Color fundus image. Acquired with a Remidio Fundus on Phone (FOP) camera
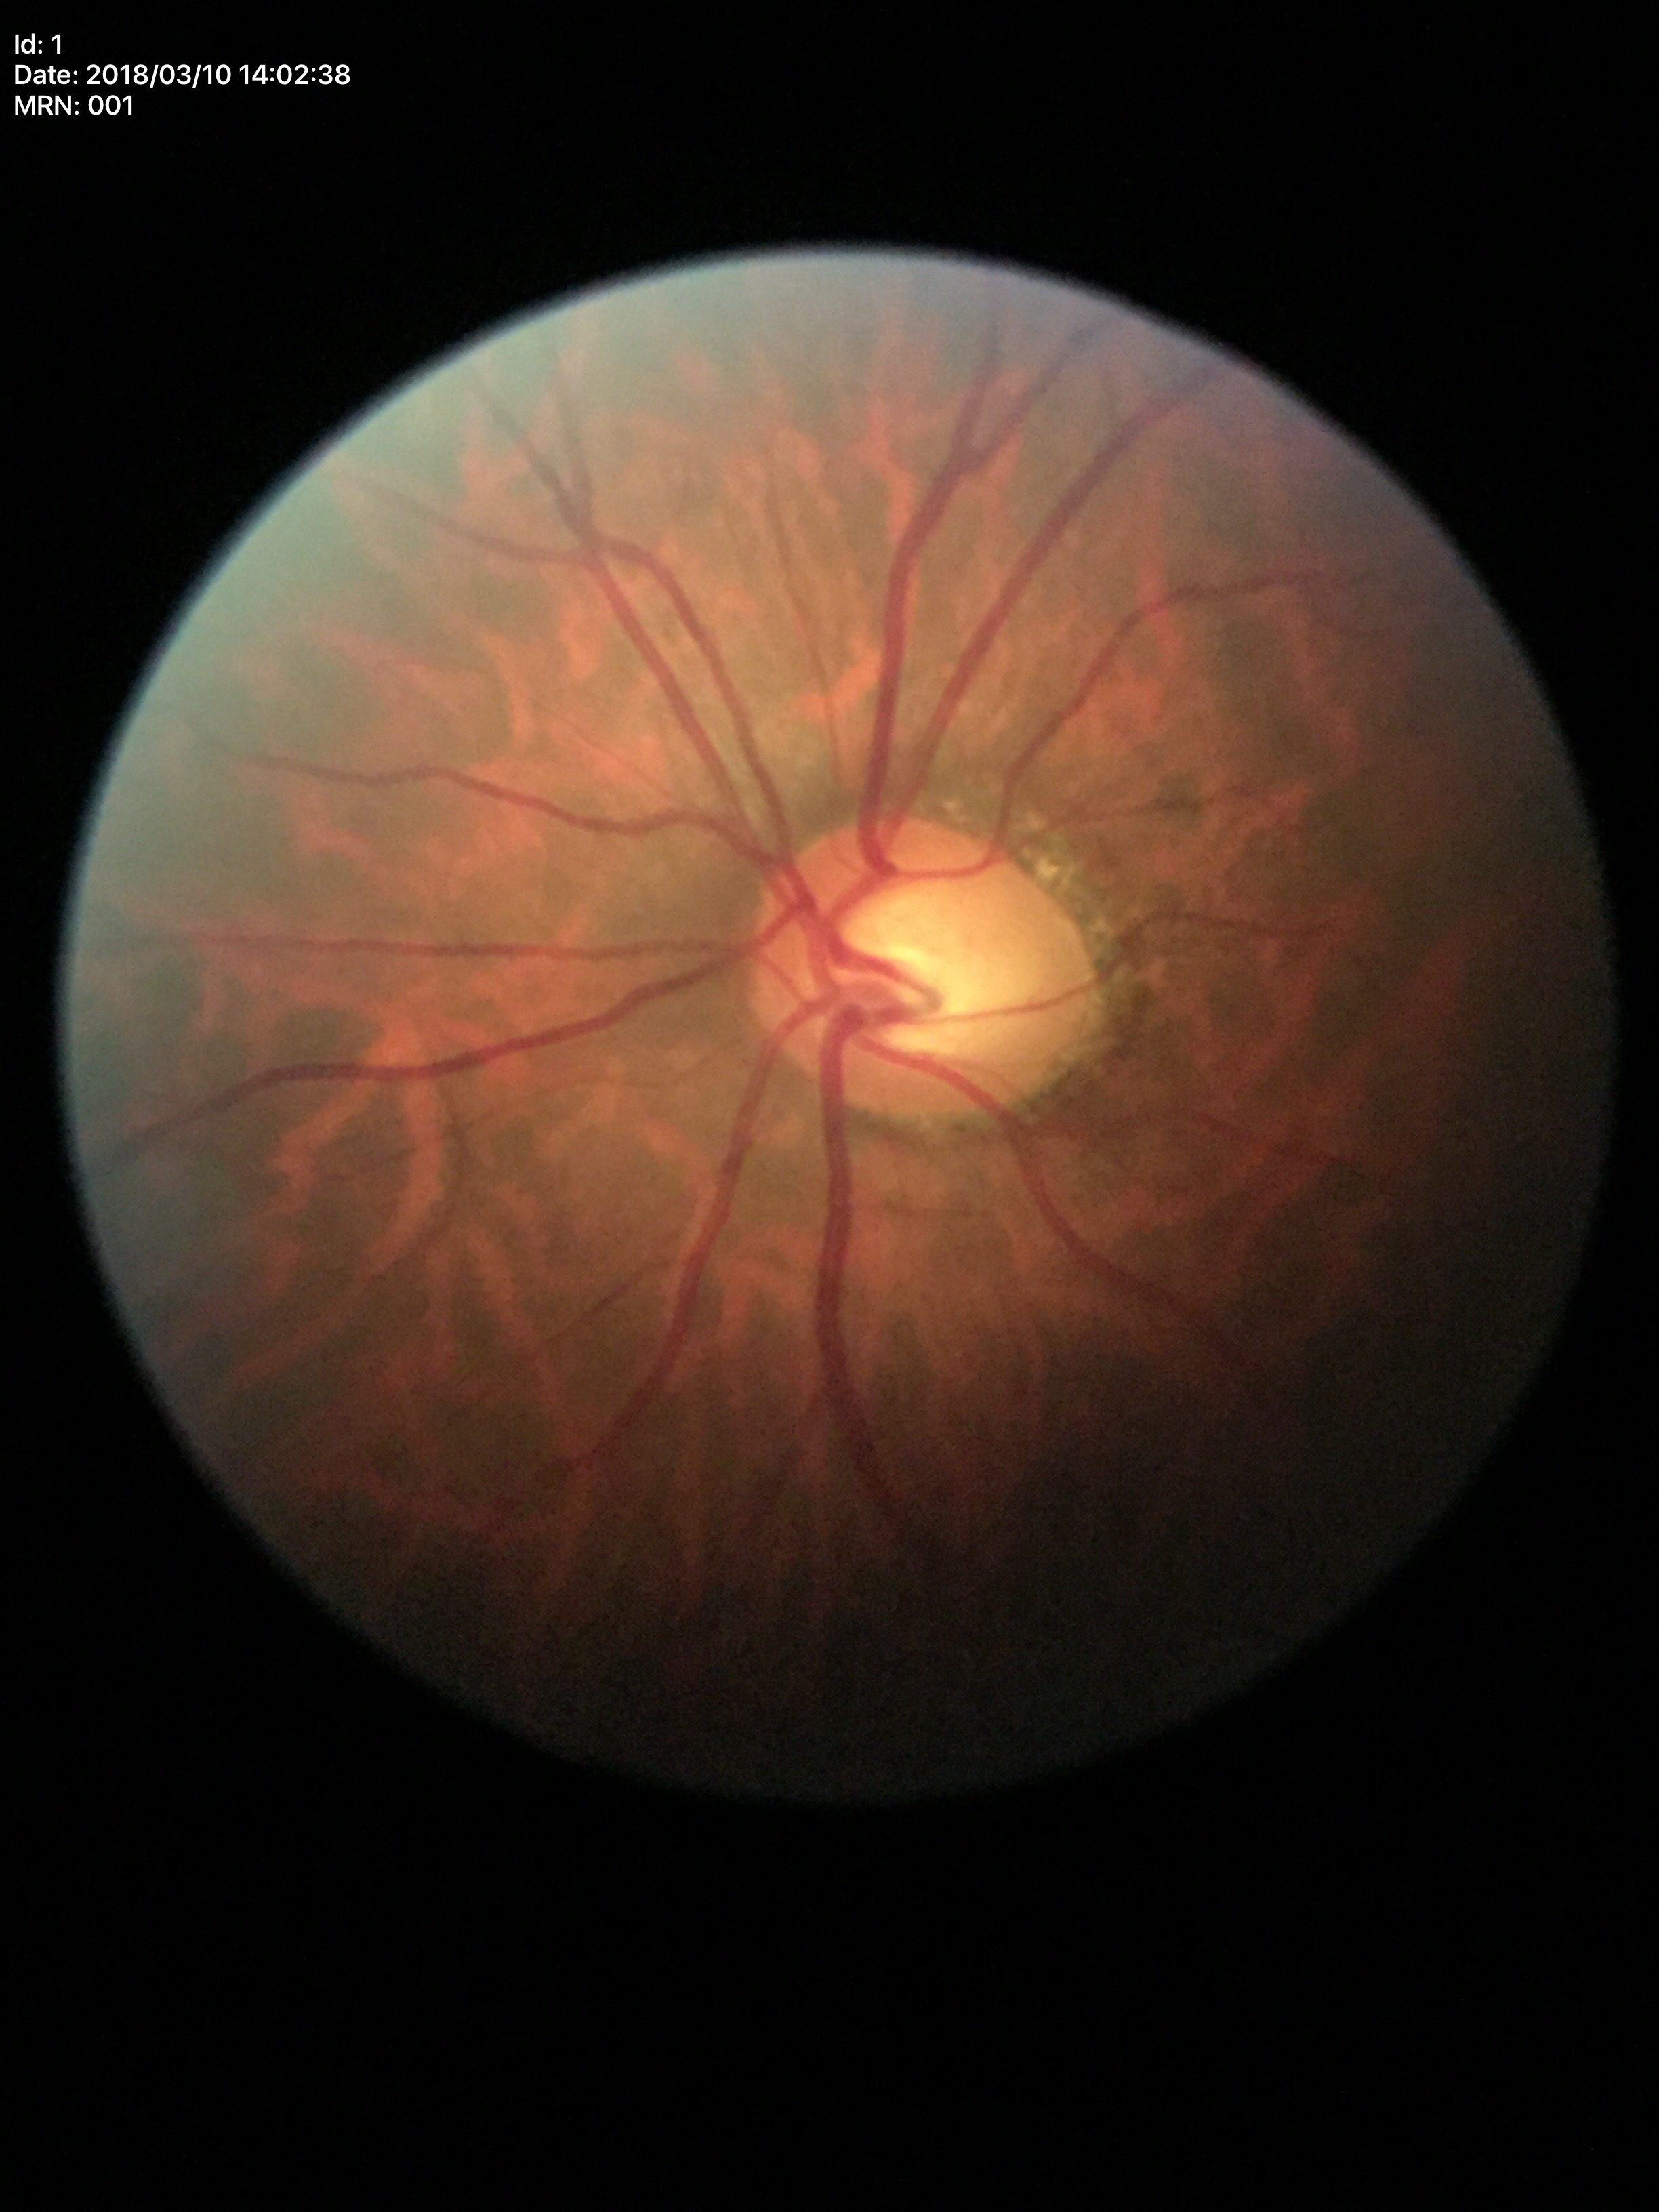
Glaucoma assessment: suspicious
vertical C/D ratio: 0.60